45° FOV
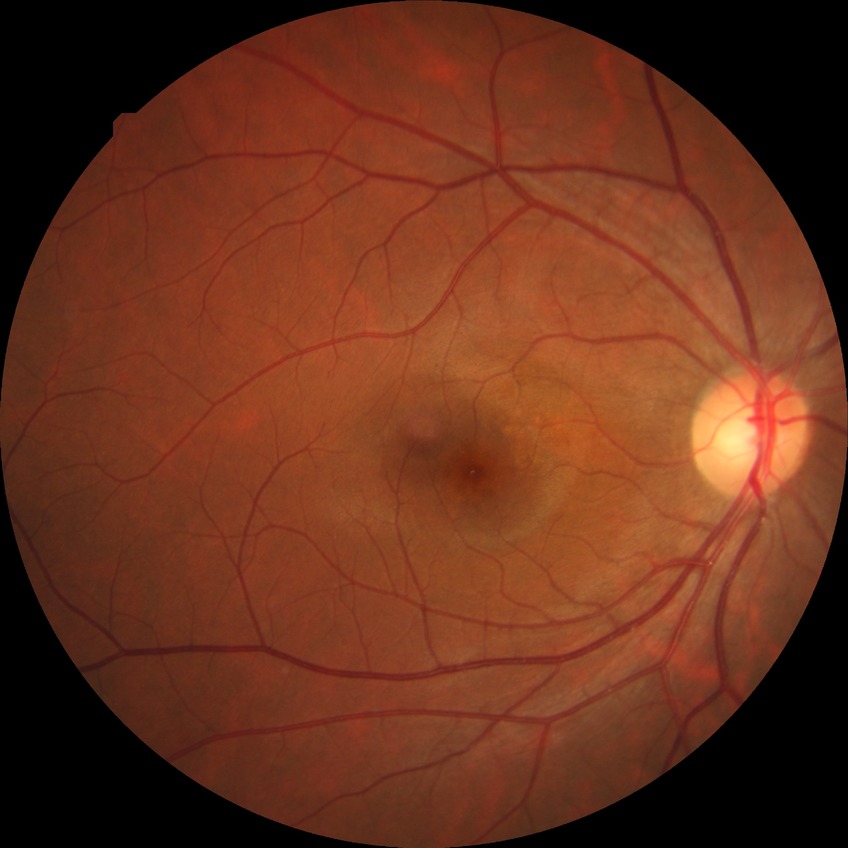 Retinopathy grade is no diabetic retinopathy.